1960 x 1897 pixels
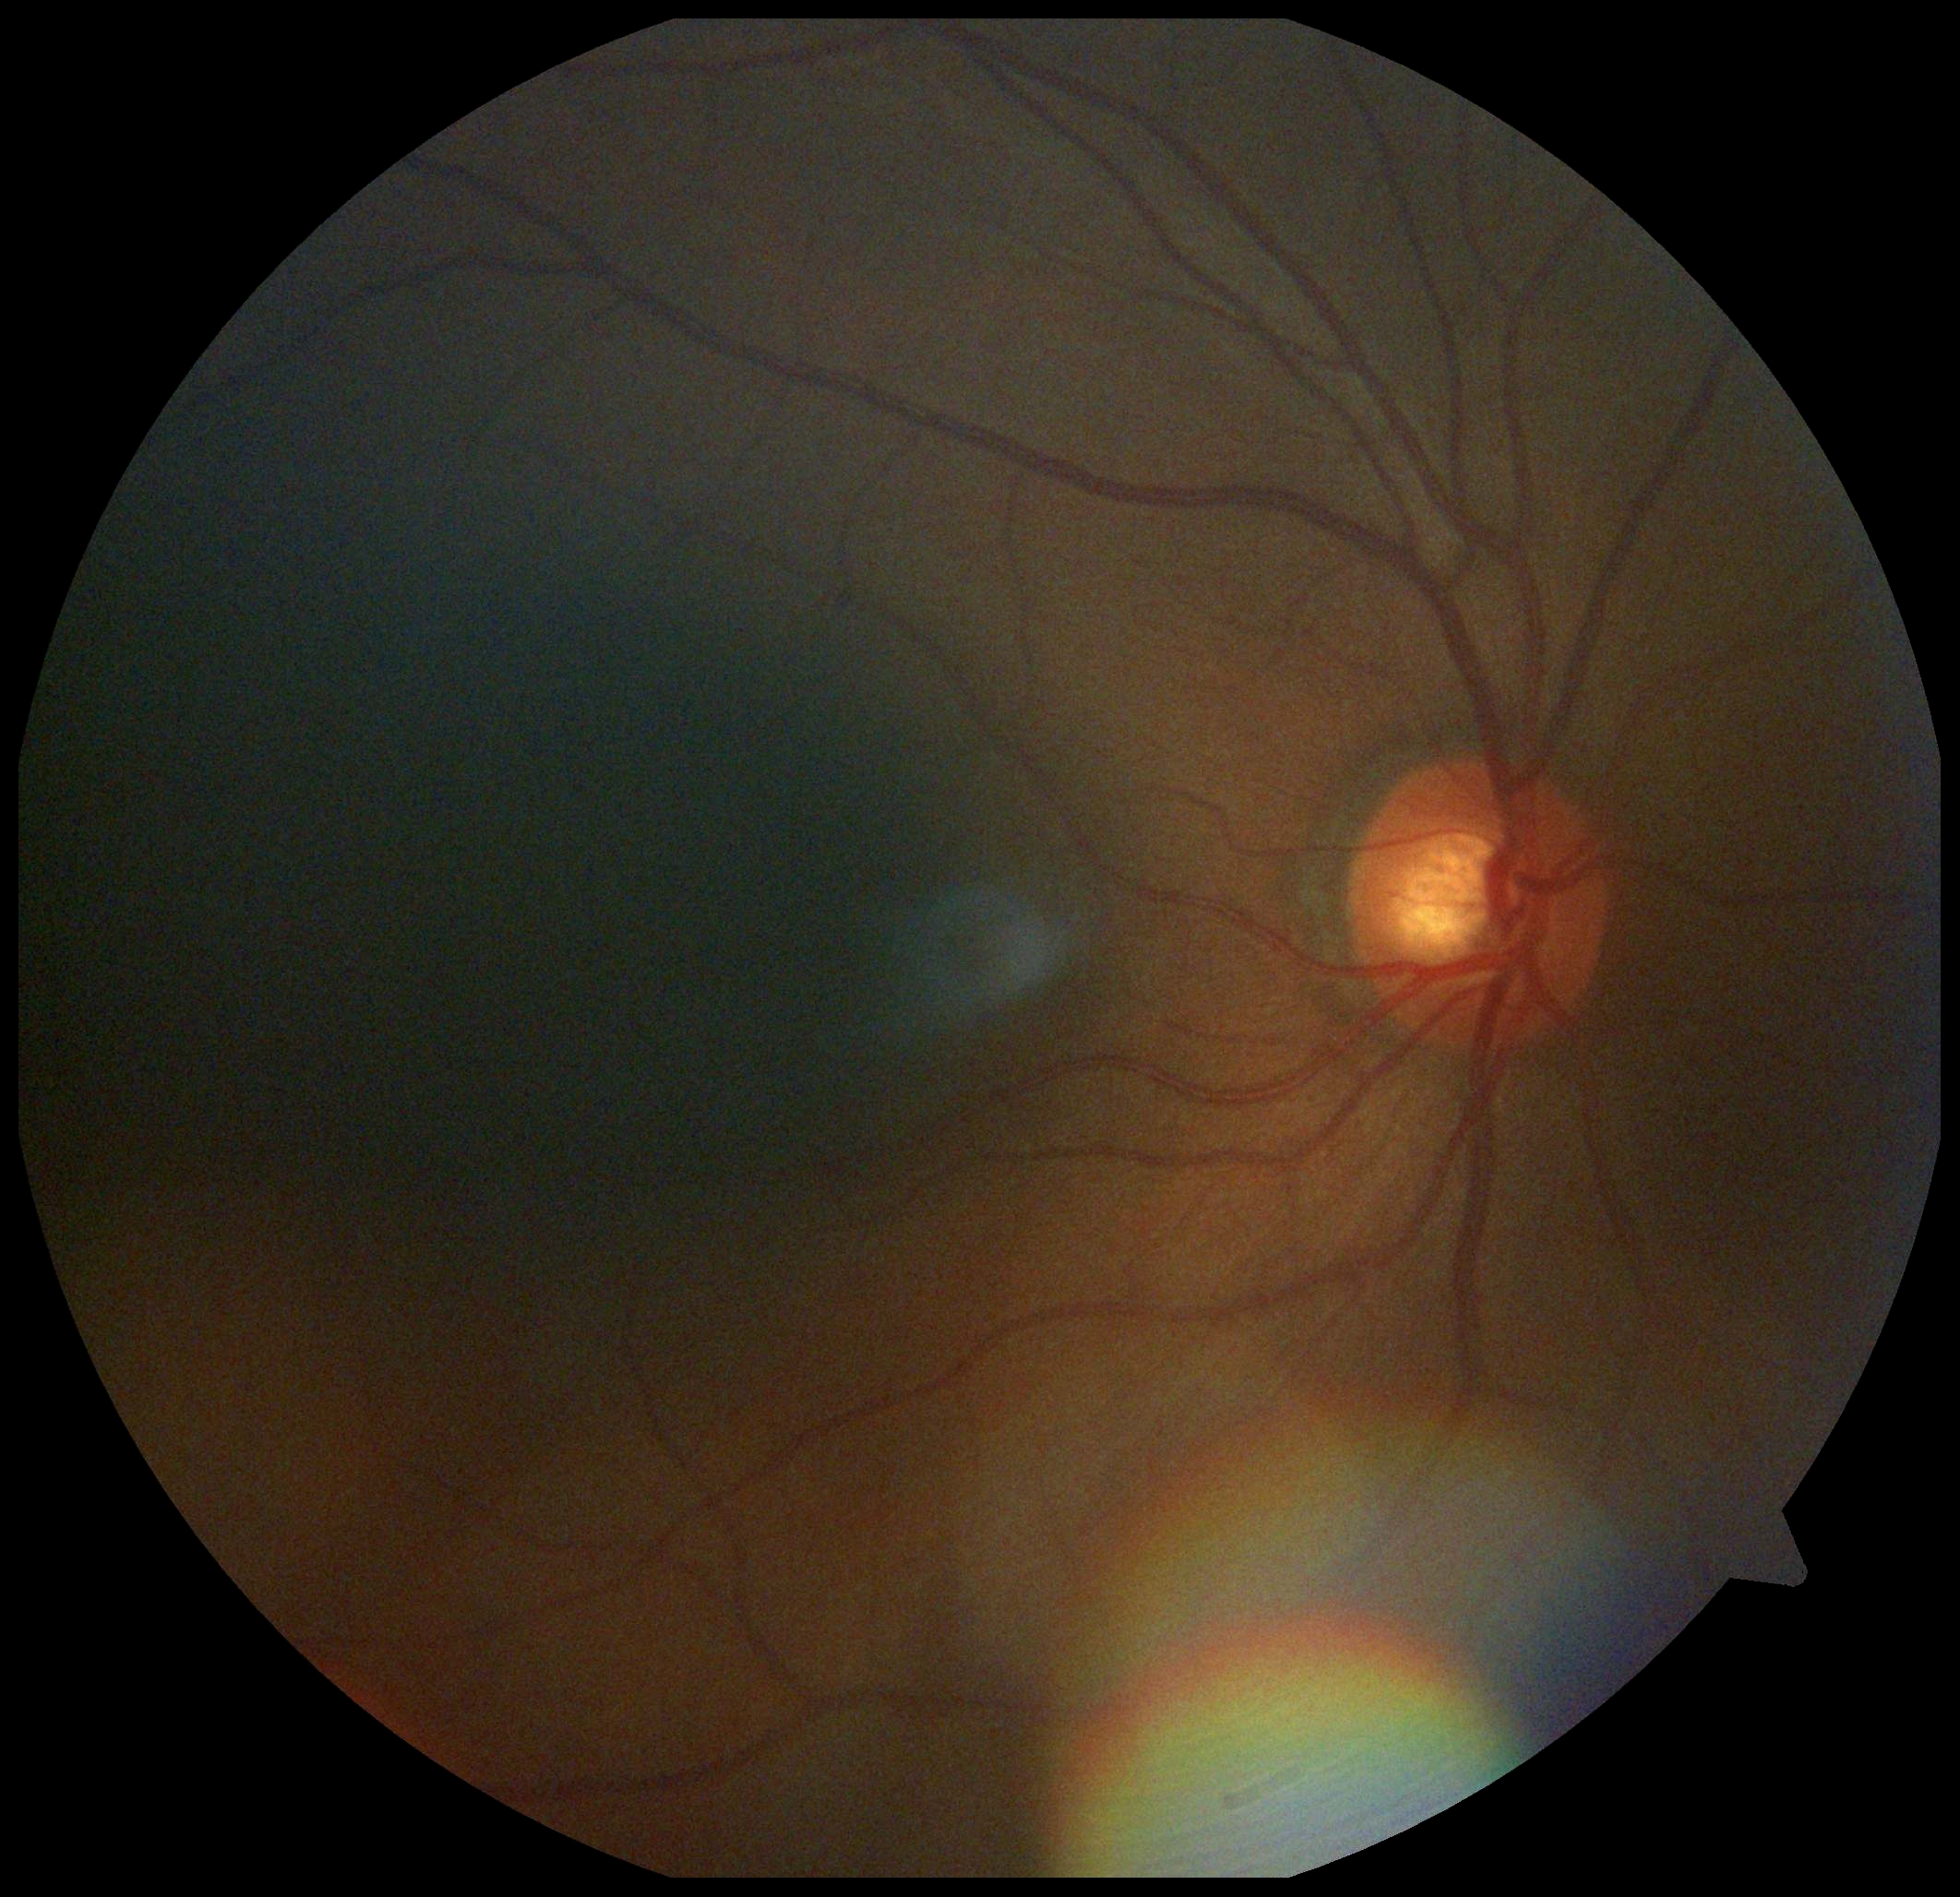 Diabetic retinopathy: grade 0 (no apparent retinopathy). No DR findings.